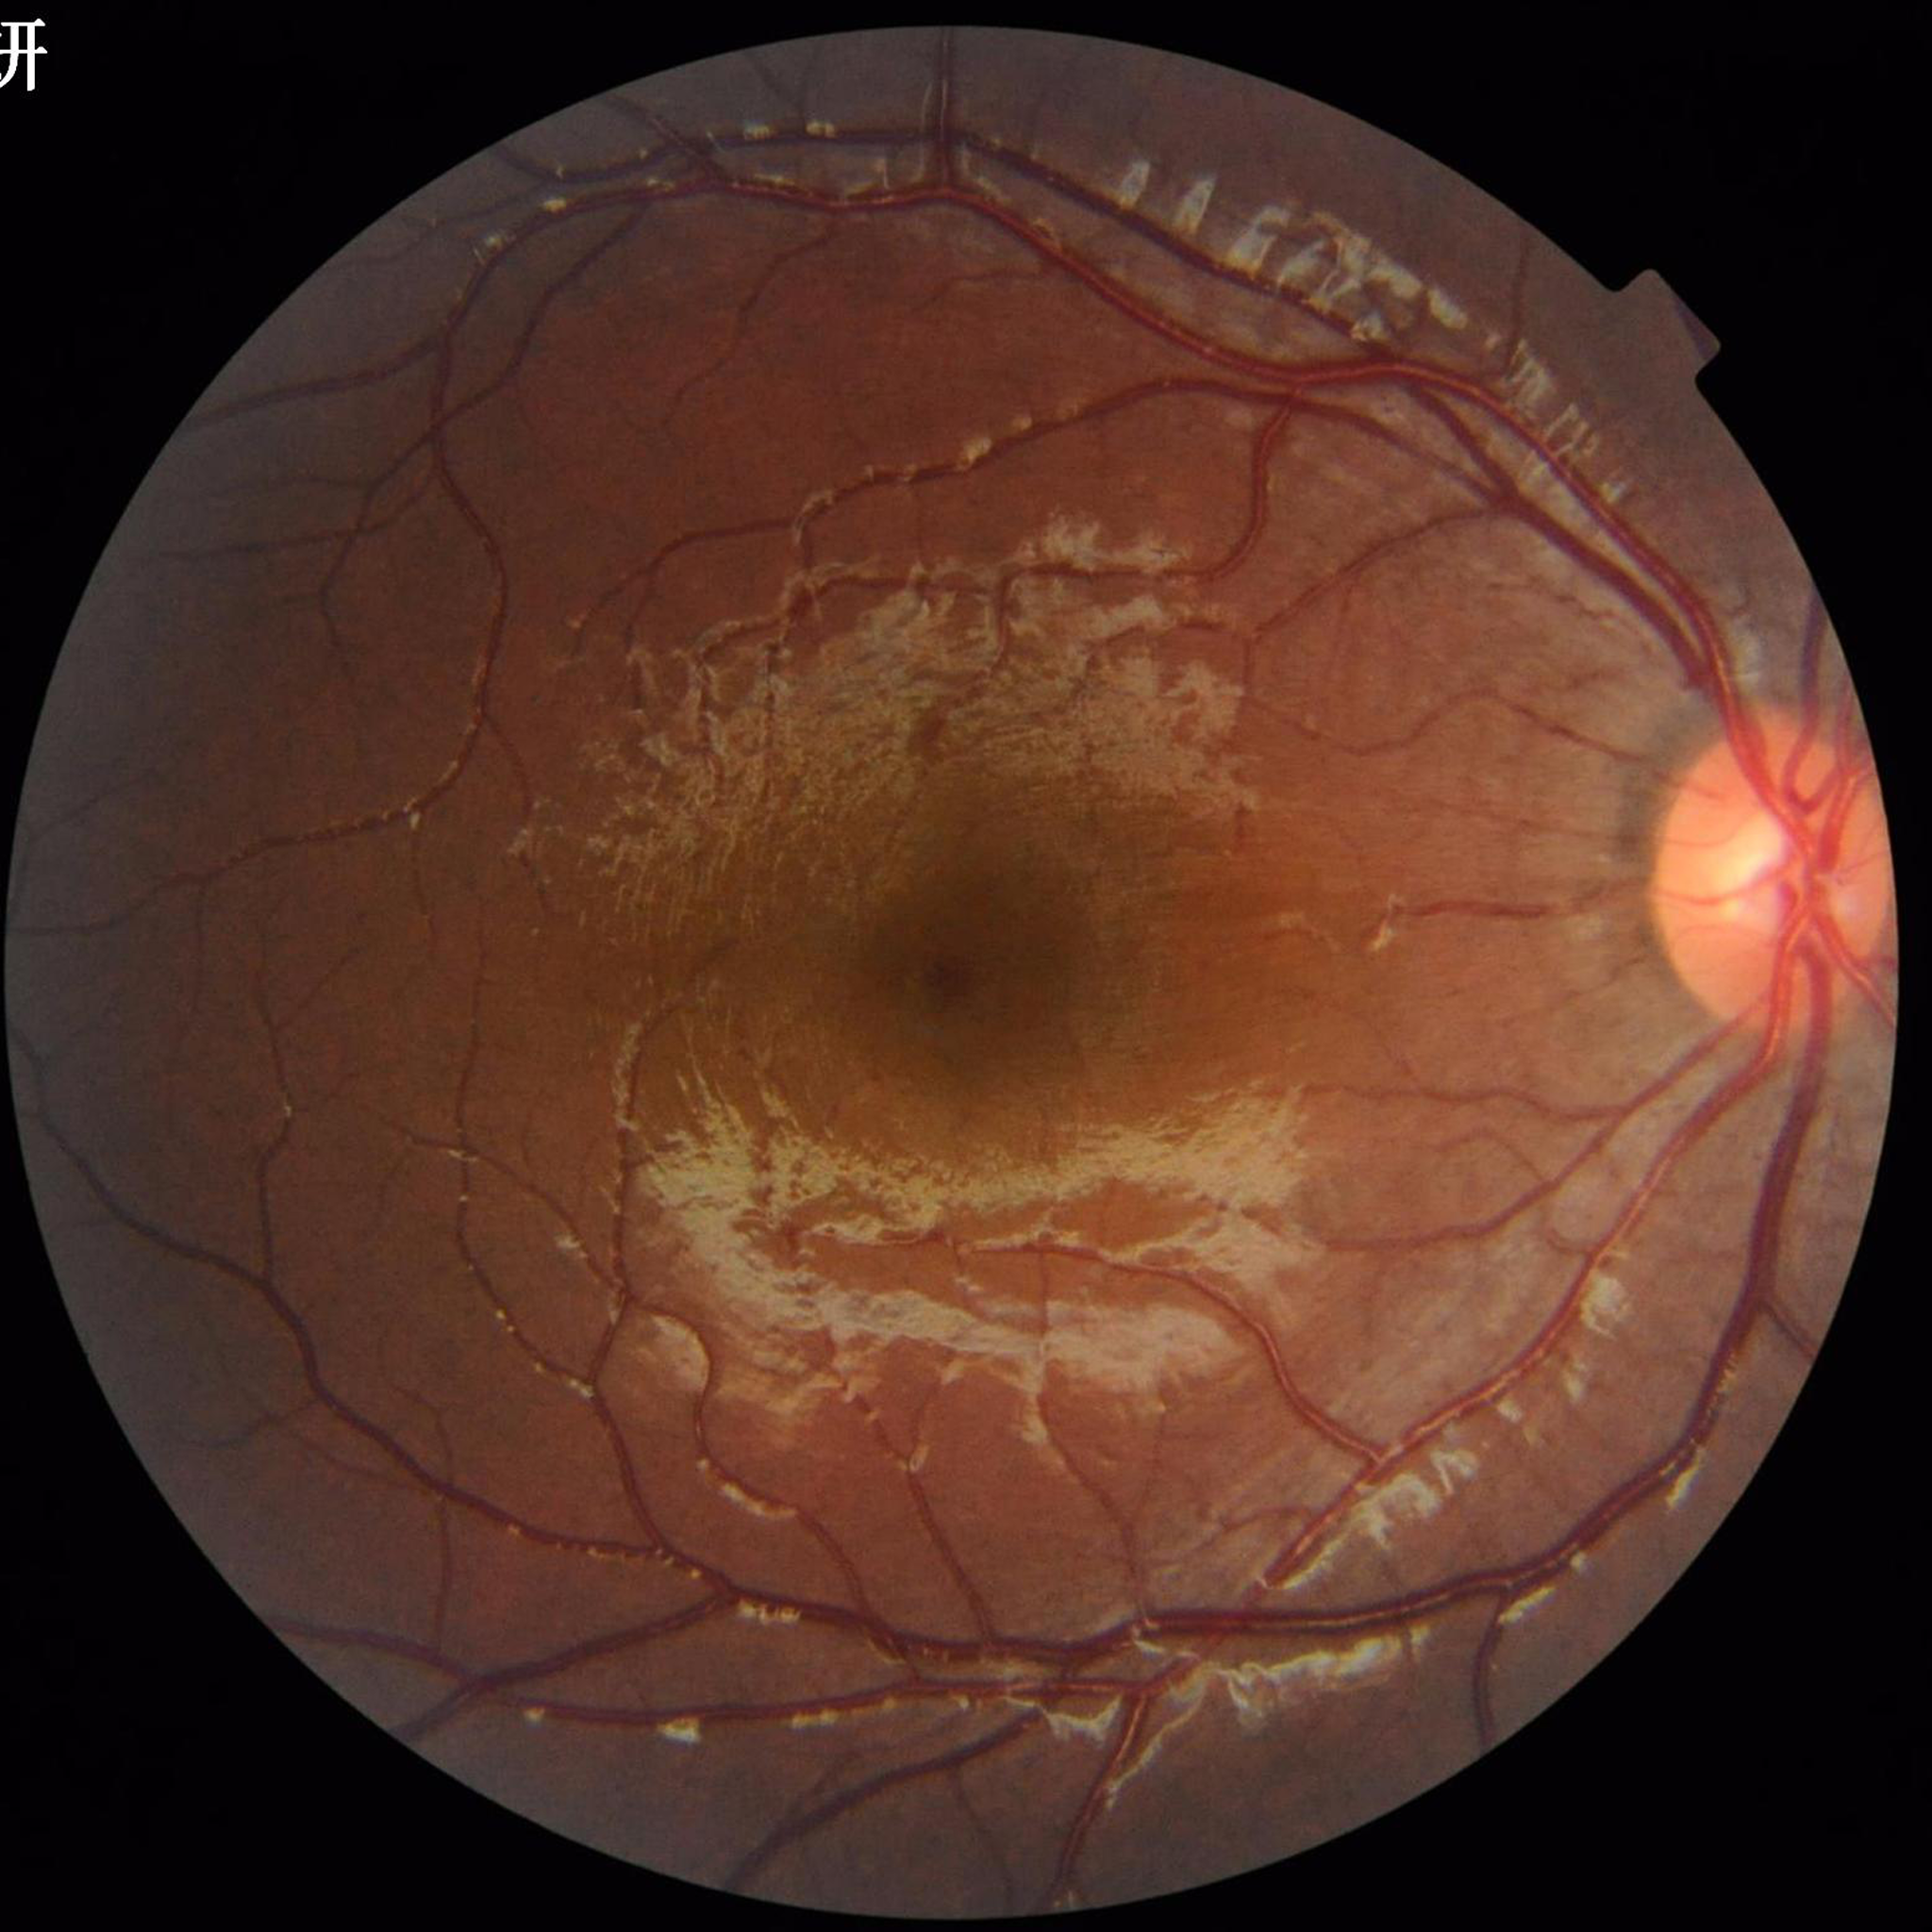 Quality: satisfactory.
Color fundus photo from a control patient without diagnosed retinal disease.